Retinal fundus photograph; 50-degree field of view — 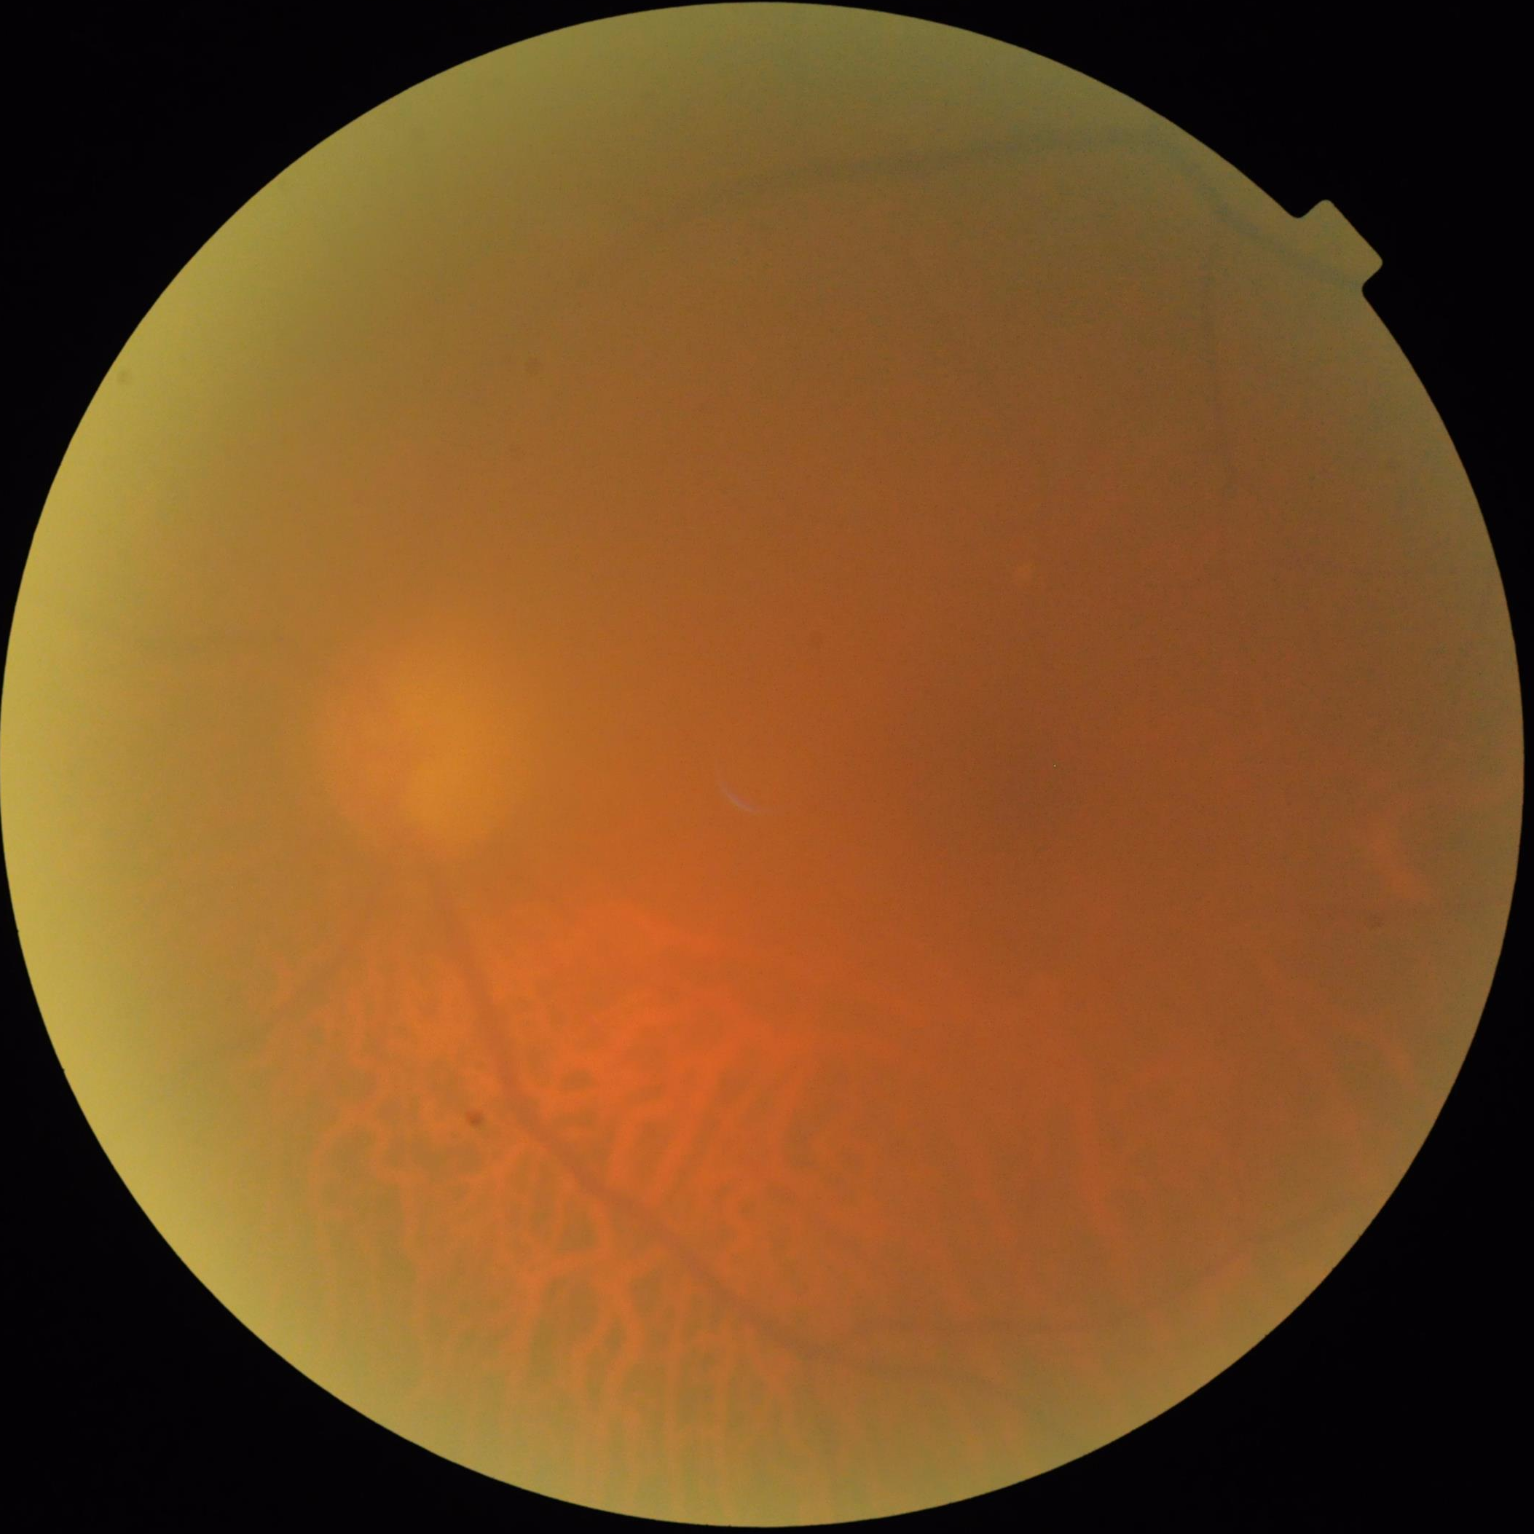
Out of focus; structures are indistinct. Overall quality is poor; the image is difficult to grade. Illumination and color are suboptimal. Vessels and details are hard to distinguish.